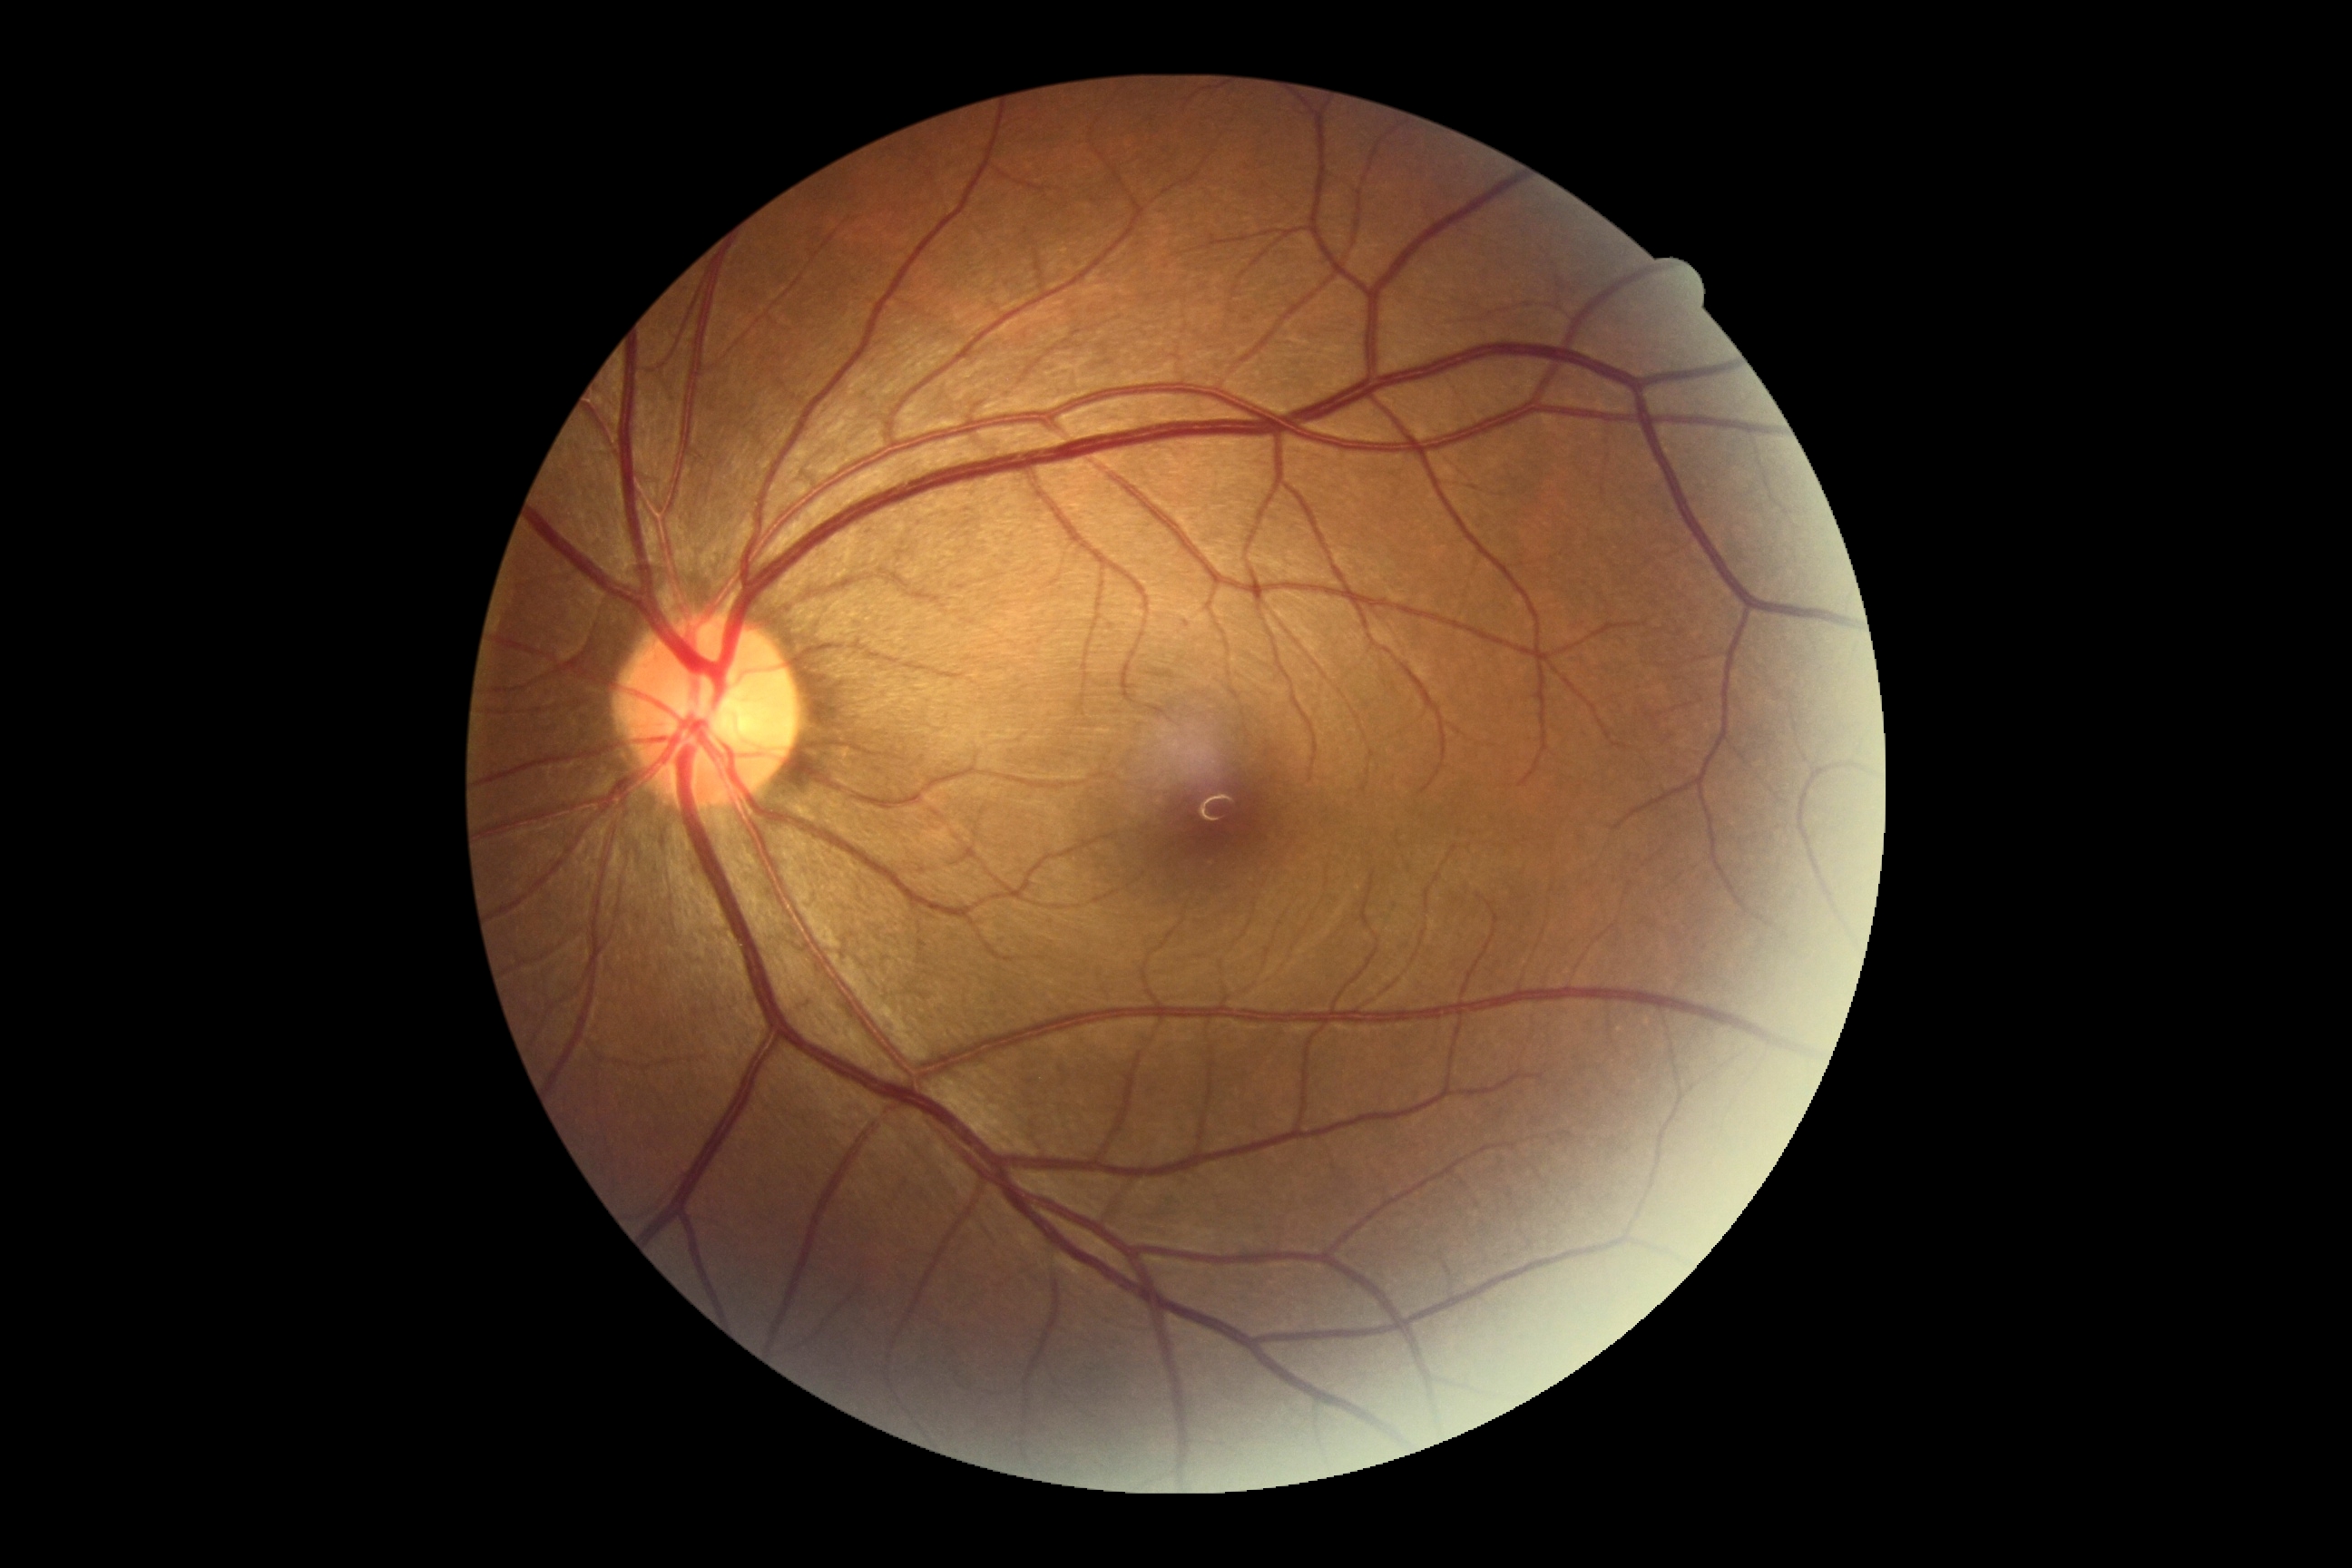
• DR impression — no apparent DR
• DR — grade 0 (no apparent retinopathy) — no visible signs of diabetic retinopathy